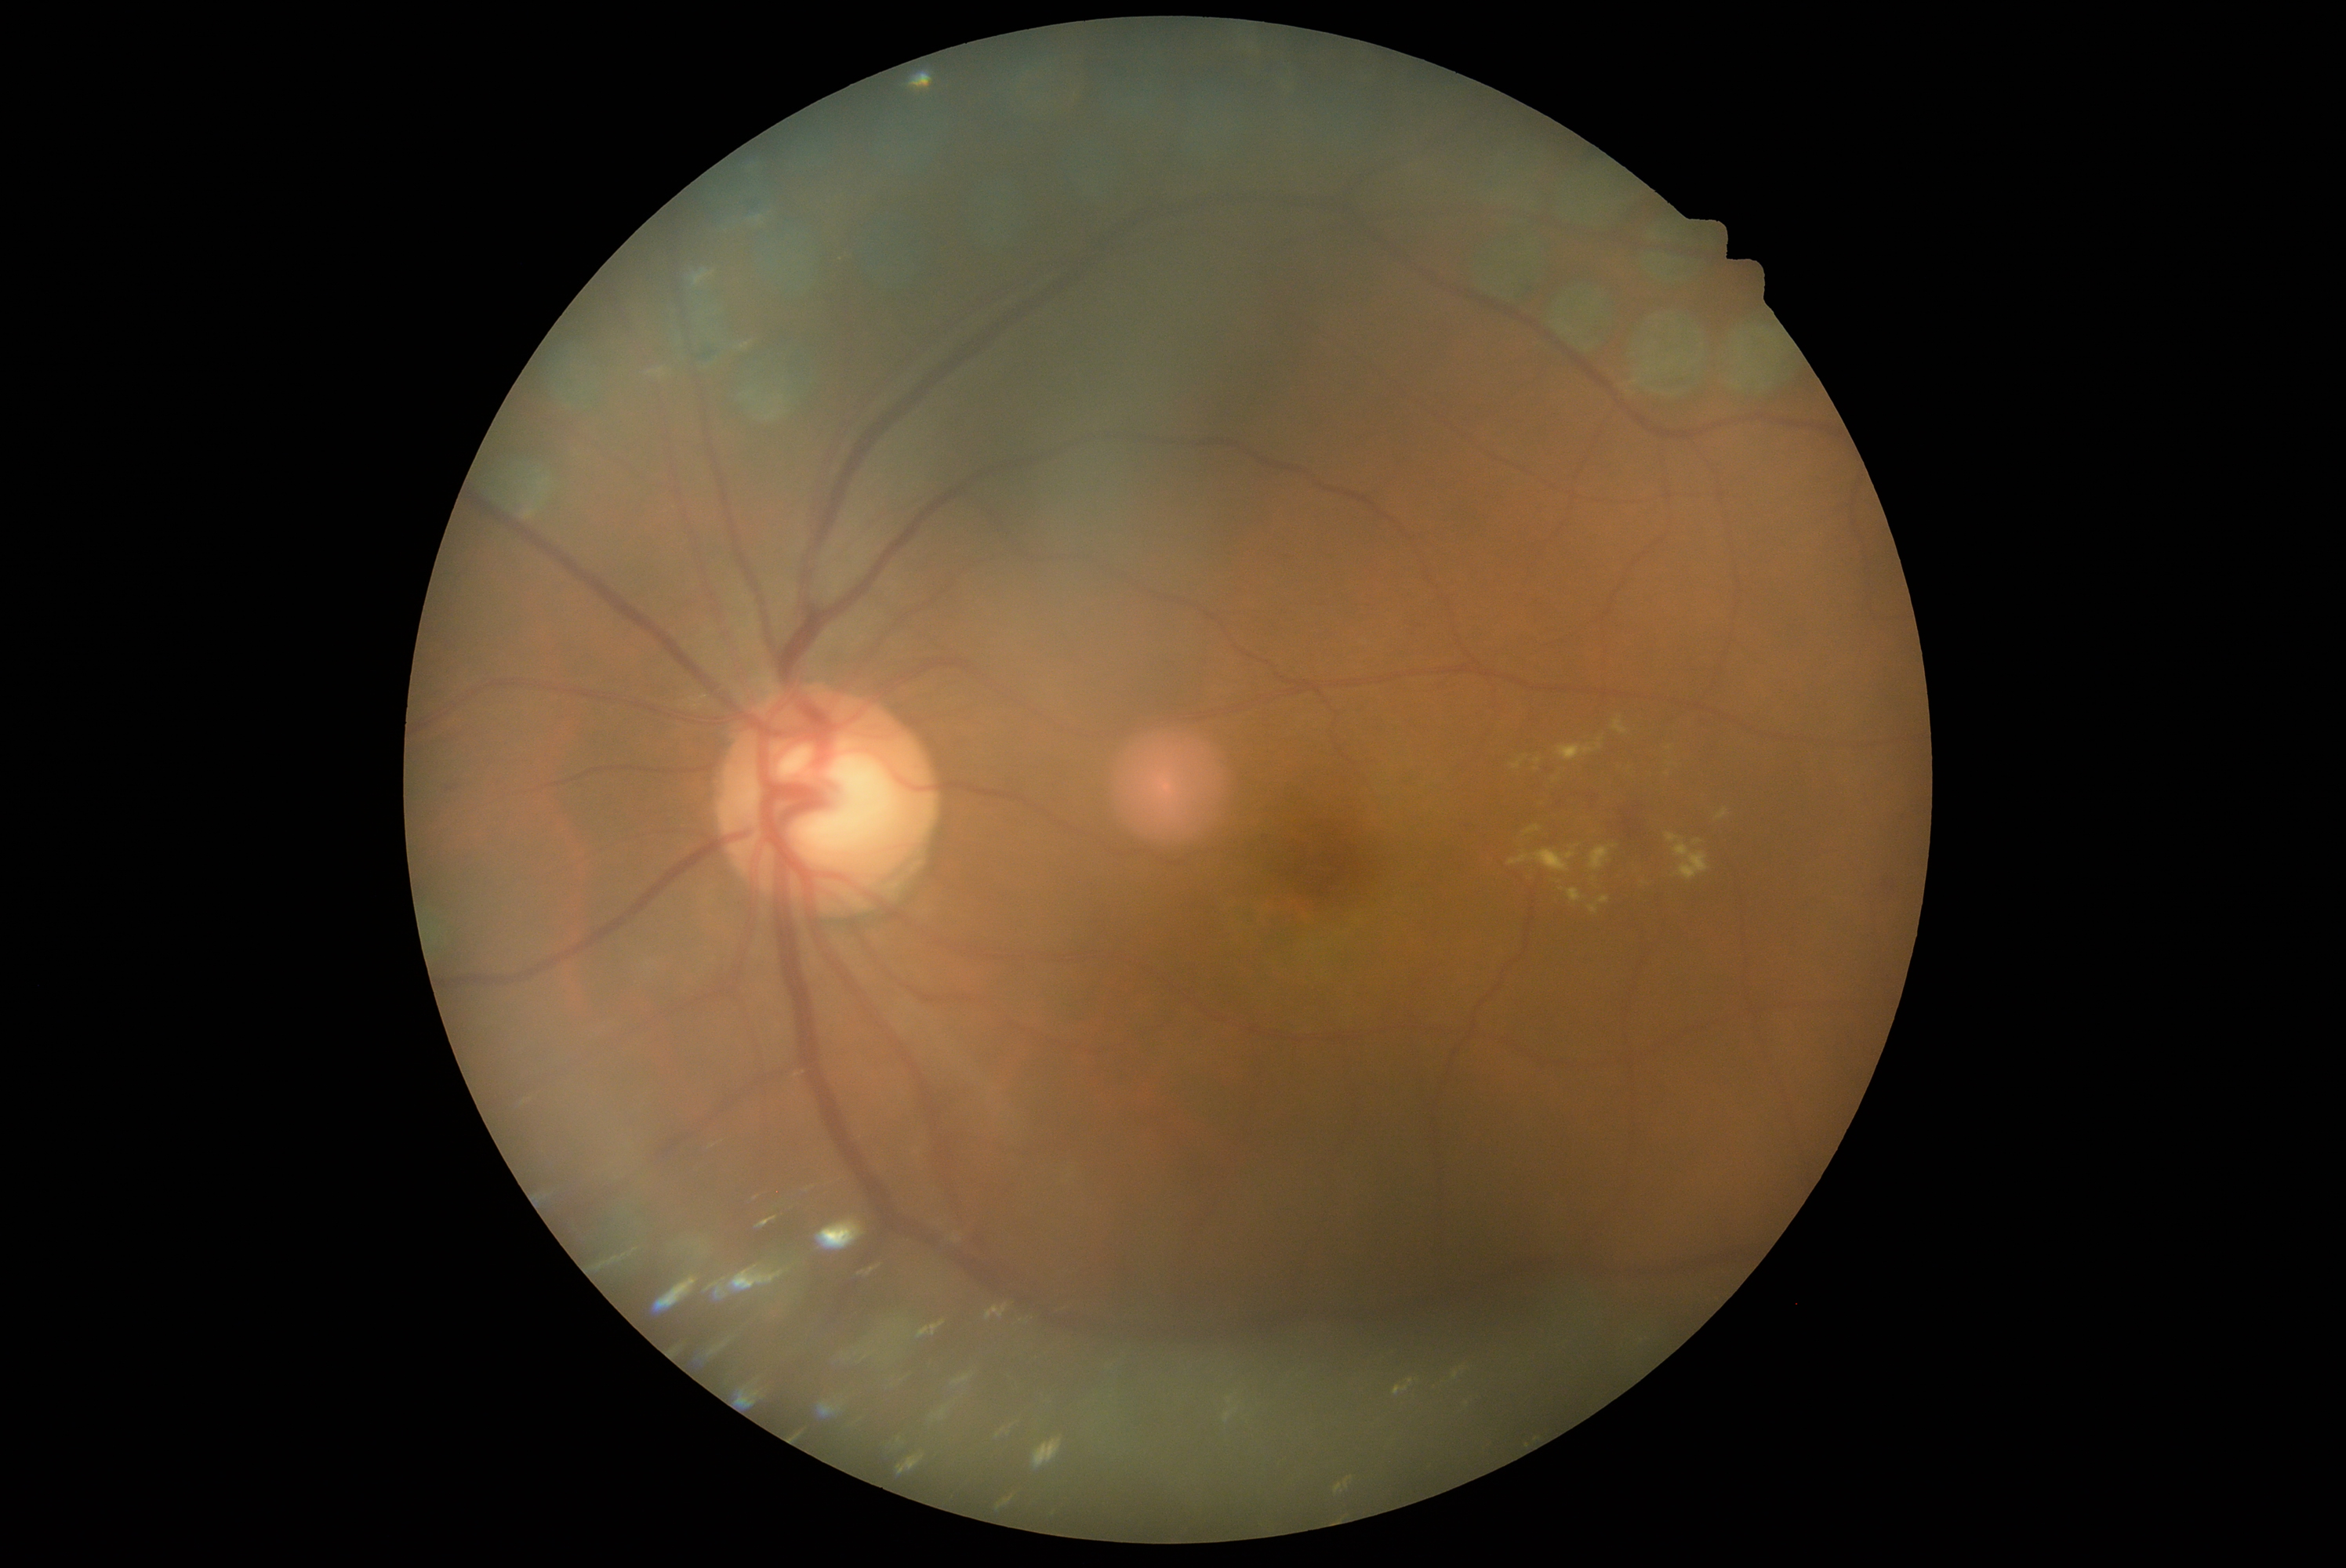

The retinopathy is classified as non-proliferative diabetic retinopathy.
Retinopathy grade: 2.